Image size 848x848 · graded on the modified Davis scale · acquired with a NIDEK AFC-230 · CFP: 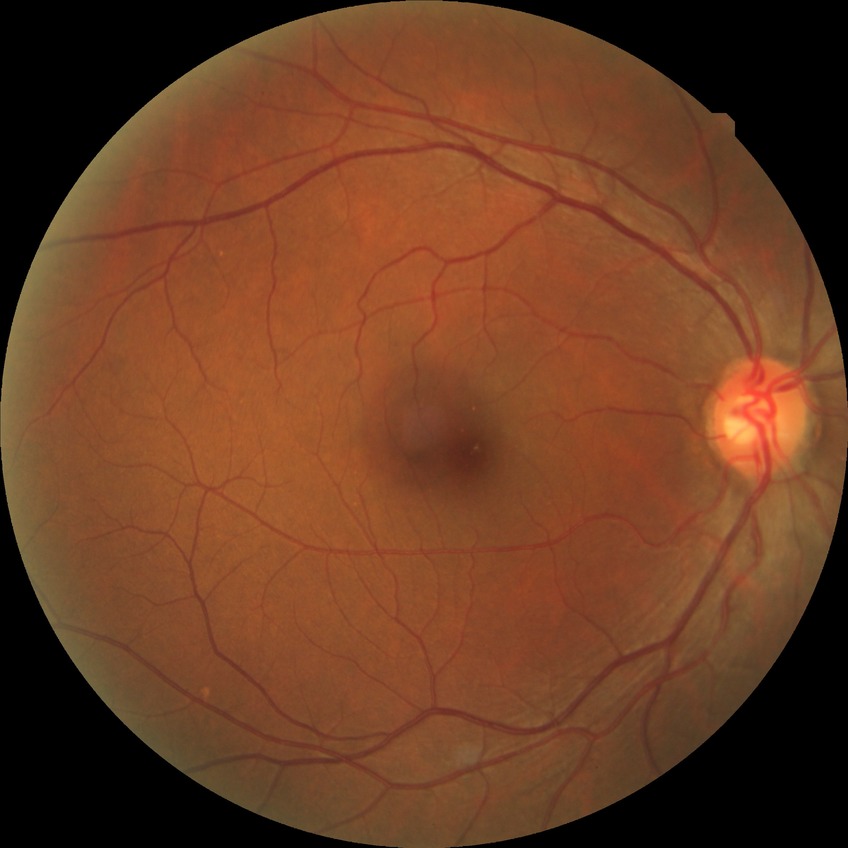

Modified Davis grade is NDR.